CFP.
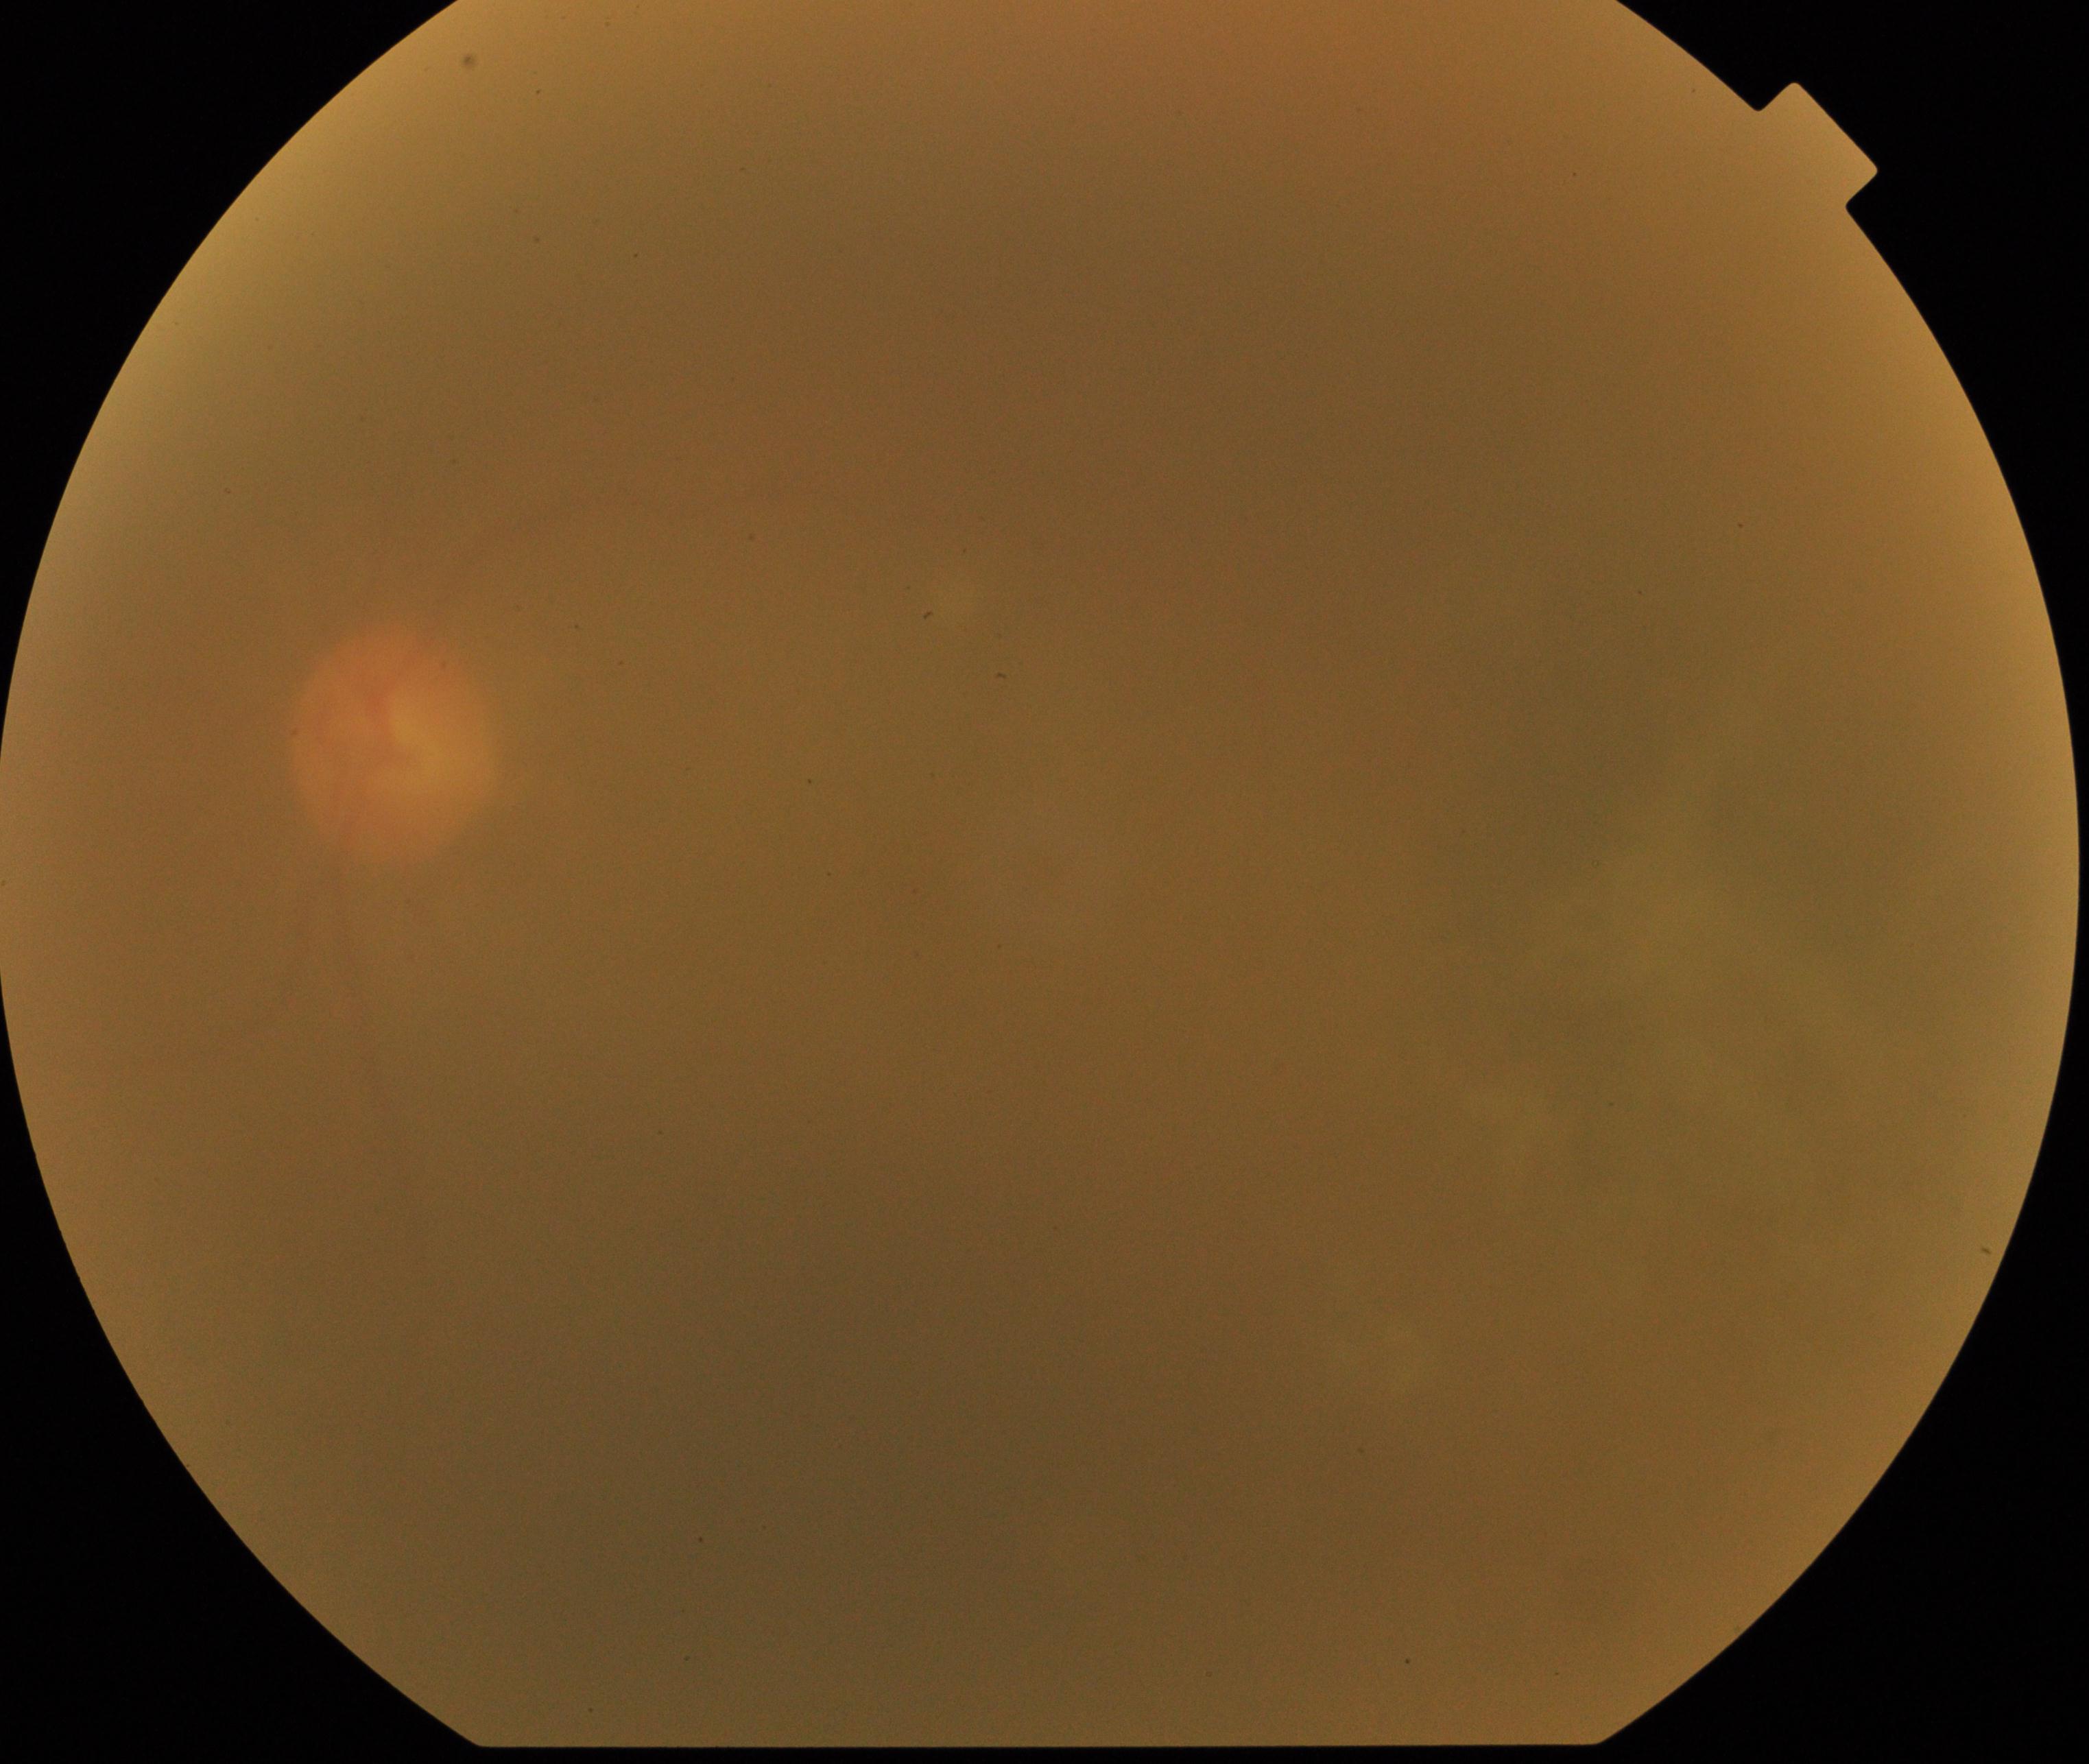

Gradability: poor, substantial obscuration of retinal landmarks.
Proliferative diabetic retinopathy: not identified.